NIDEK AFC-230.
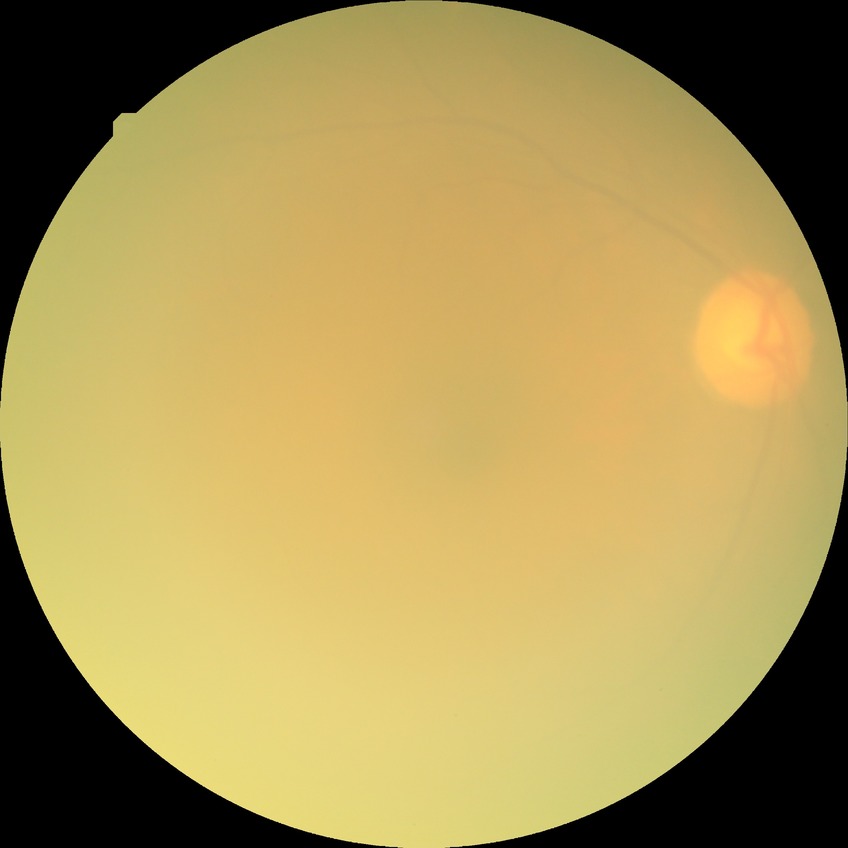

Davis grade@NDR, DR impression@no DR findings.